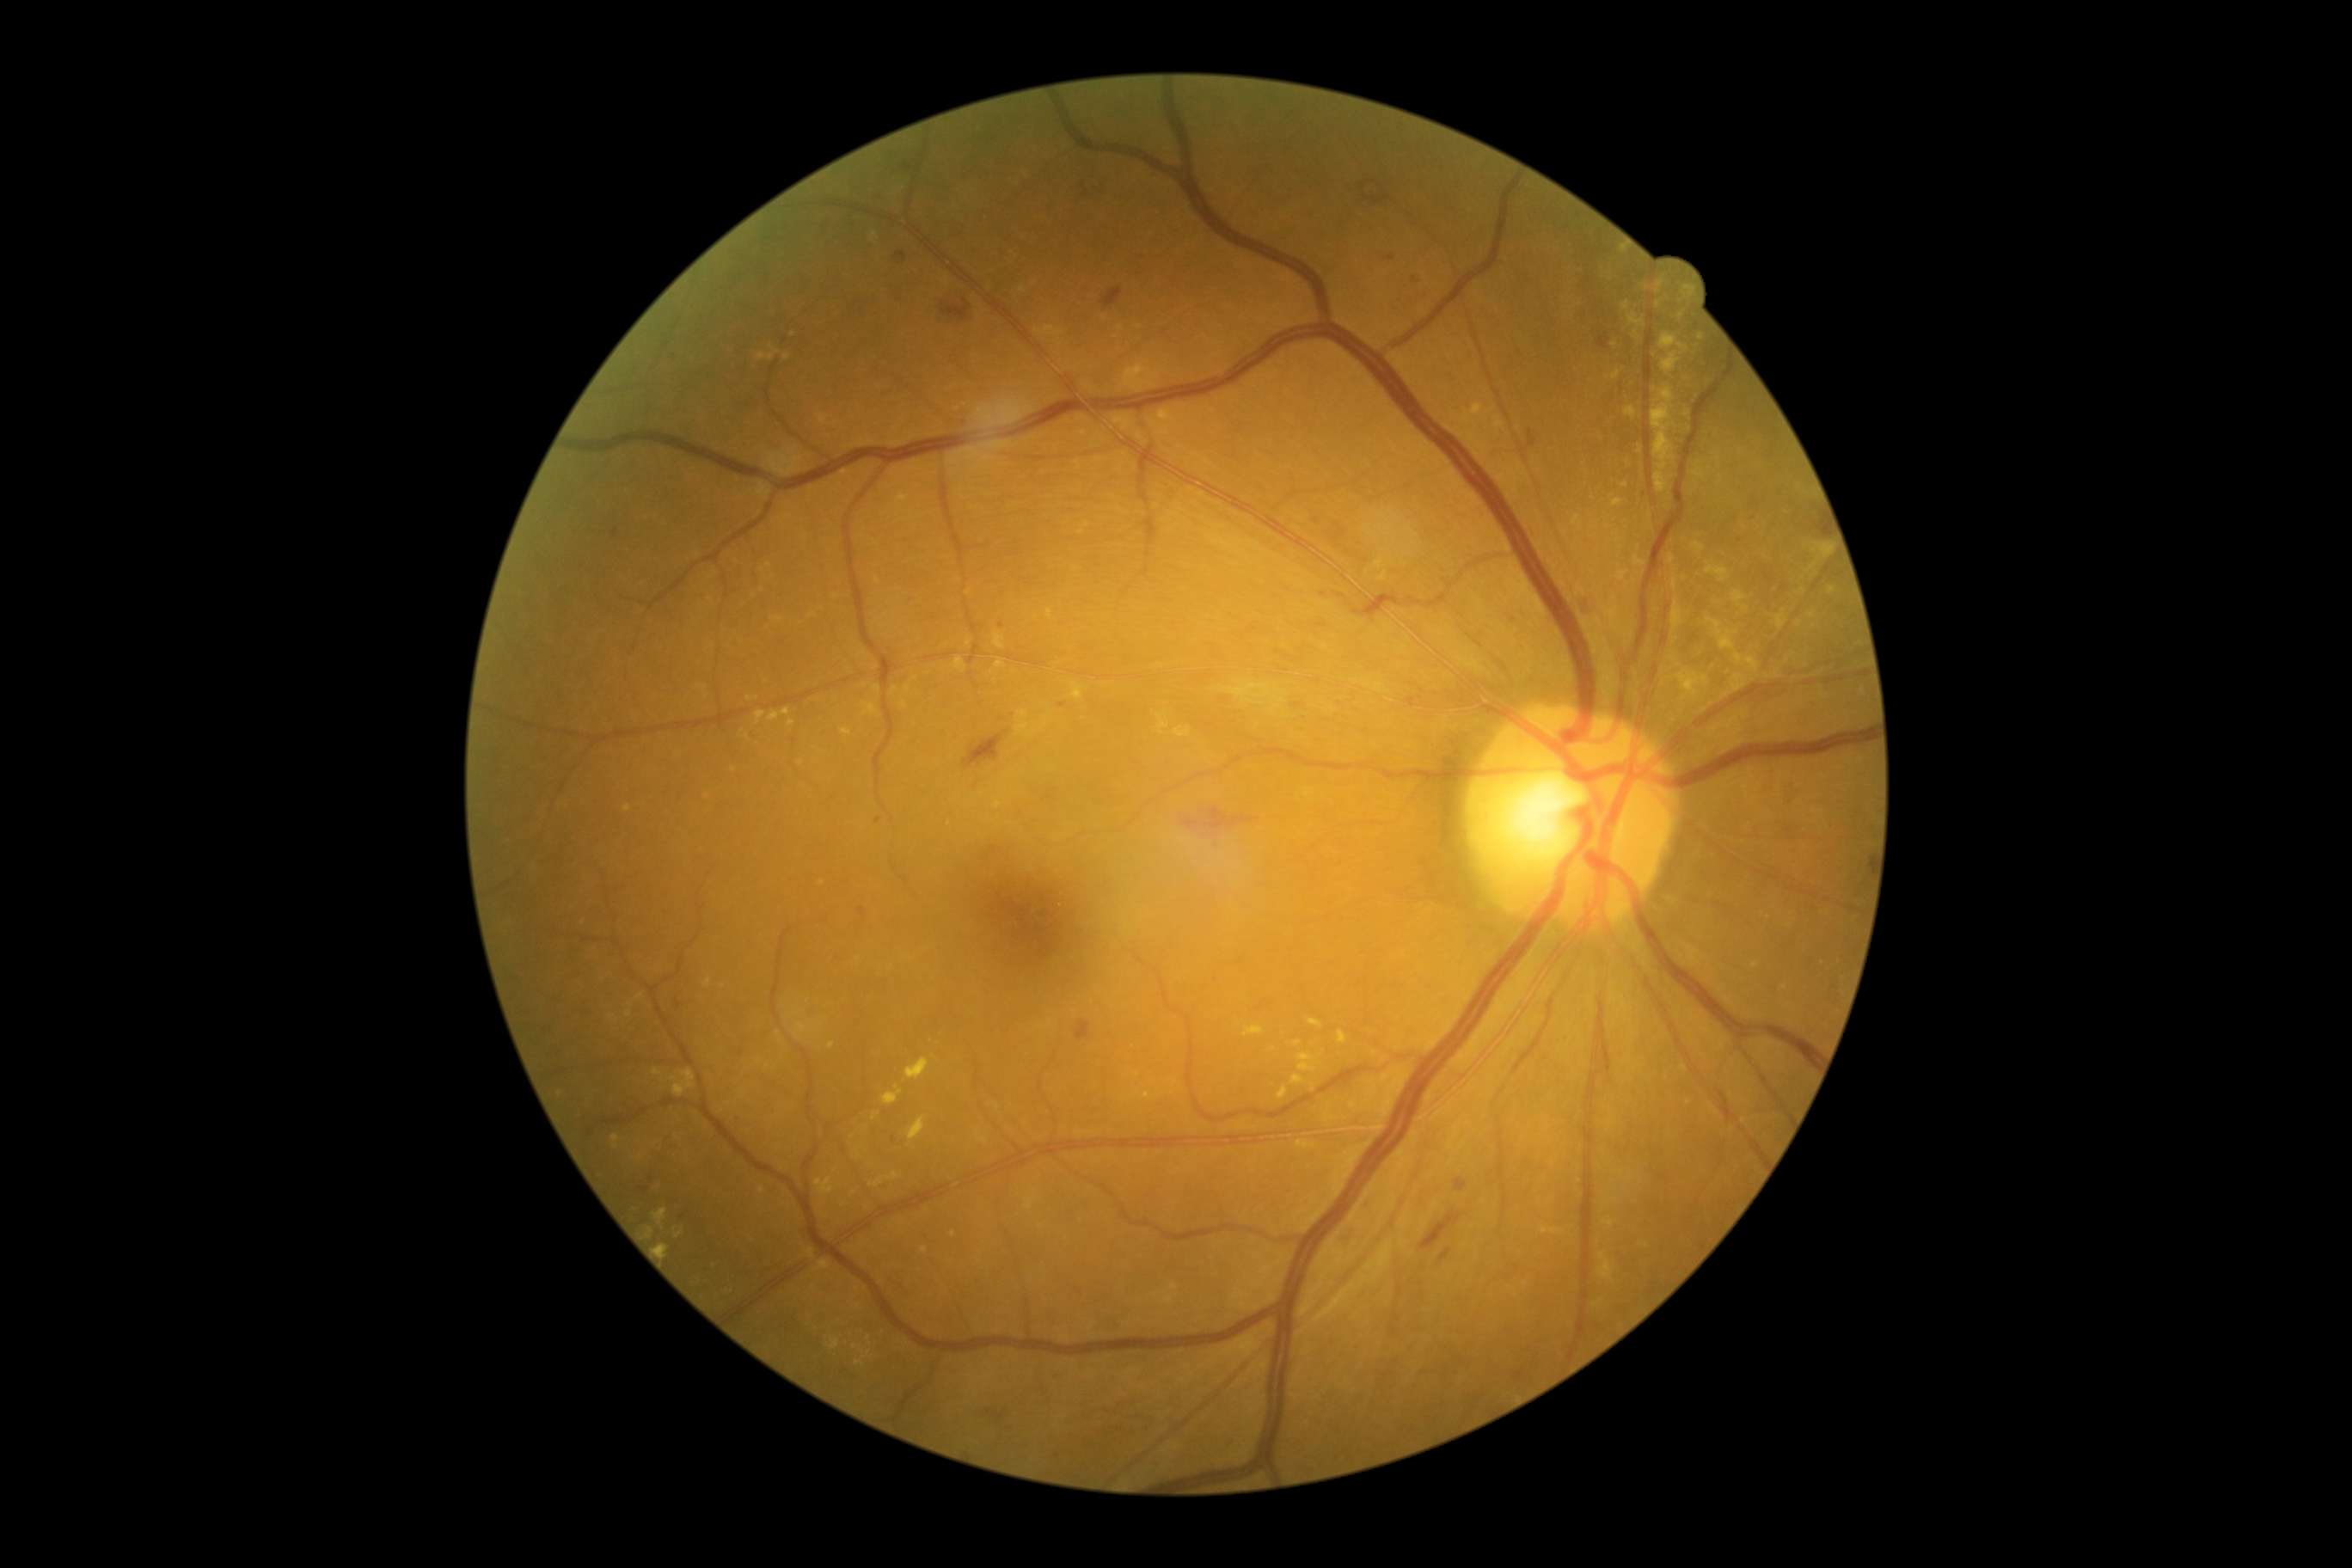
Retinopathy grade: moderate non-proliferative diabetic retinopathy (2).
Hemorrhages (partial list) at (1596,331,1610,352), (1337,1228,1351,1246), (893,252,907,266), (1099,286,1124,312), (1235,957,1247,965), (1455,1179,1467,1192), (1361,1204,1369,1210), (1357,178,1400,209), (938,297,972,326), (962,728,1014,771), (1098,1320,1117,1332).
Microaneurysms (partial list) at (1584,278,1593,285), (1320,592,1328,597), (1053,1452,1060,1461), (1514,1369,1526,1381), (609,527,622,539), (1313,517,1323,525), (1383,254,1397,262), (680,1213,689,1222), (876,816,883,824), (1749,501,1760,508).
Microaneurysms (small, approximate centers) near Point(661, 1159), Point(794, 741), Point(1741, 540), Point(1001, 720).
Hard exudates (partial list) at (1122,362,1161,393), (1622,303,1631,310), (881,1086,903,1106), (1292,1075,1304,1084), (1670,597,1682,642), (1691,541,1705,556), (1620,482,1629,487), (654,1210,668,1227), (1338,1031,1347,1044), (1046,609,1053,620), (1473,403,1485,417), (1655,281,1665,295).
Hard exudates (small, approximate centers) near Point(1655, 390), Point(1765, 721), Point(1636, 336), Point(1812, 615), Point(1275, 1049), Point(704, 687).